2089 x 1764 pixels. Color fundus photograph: 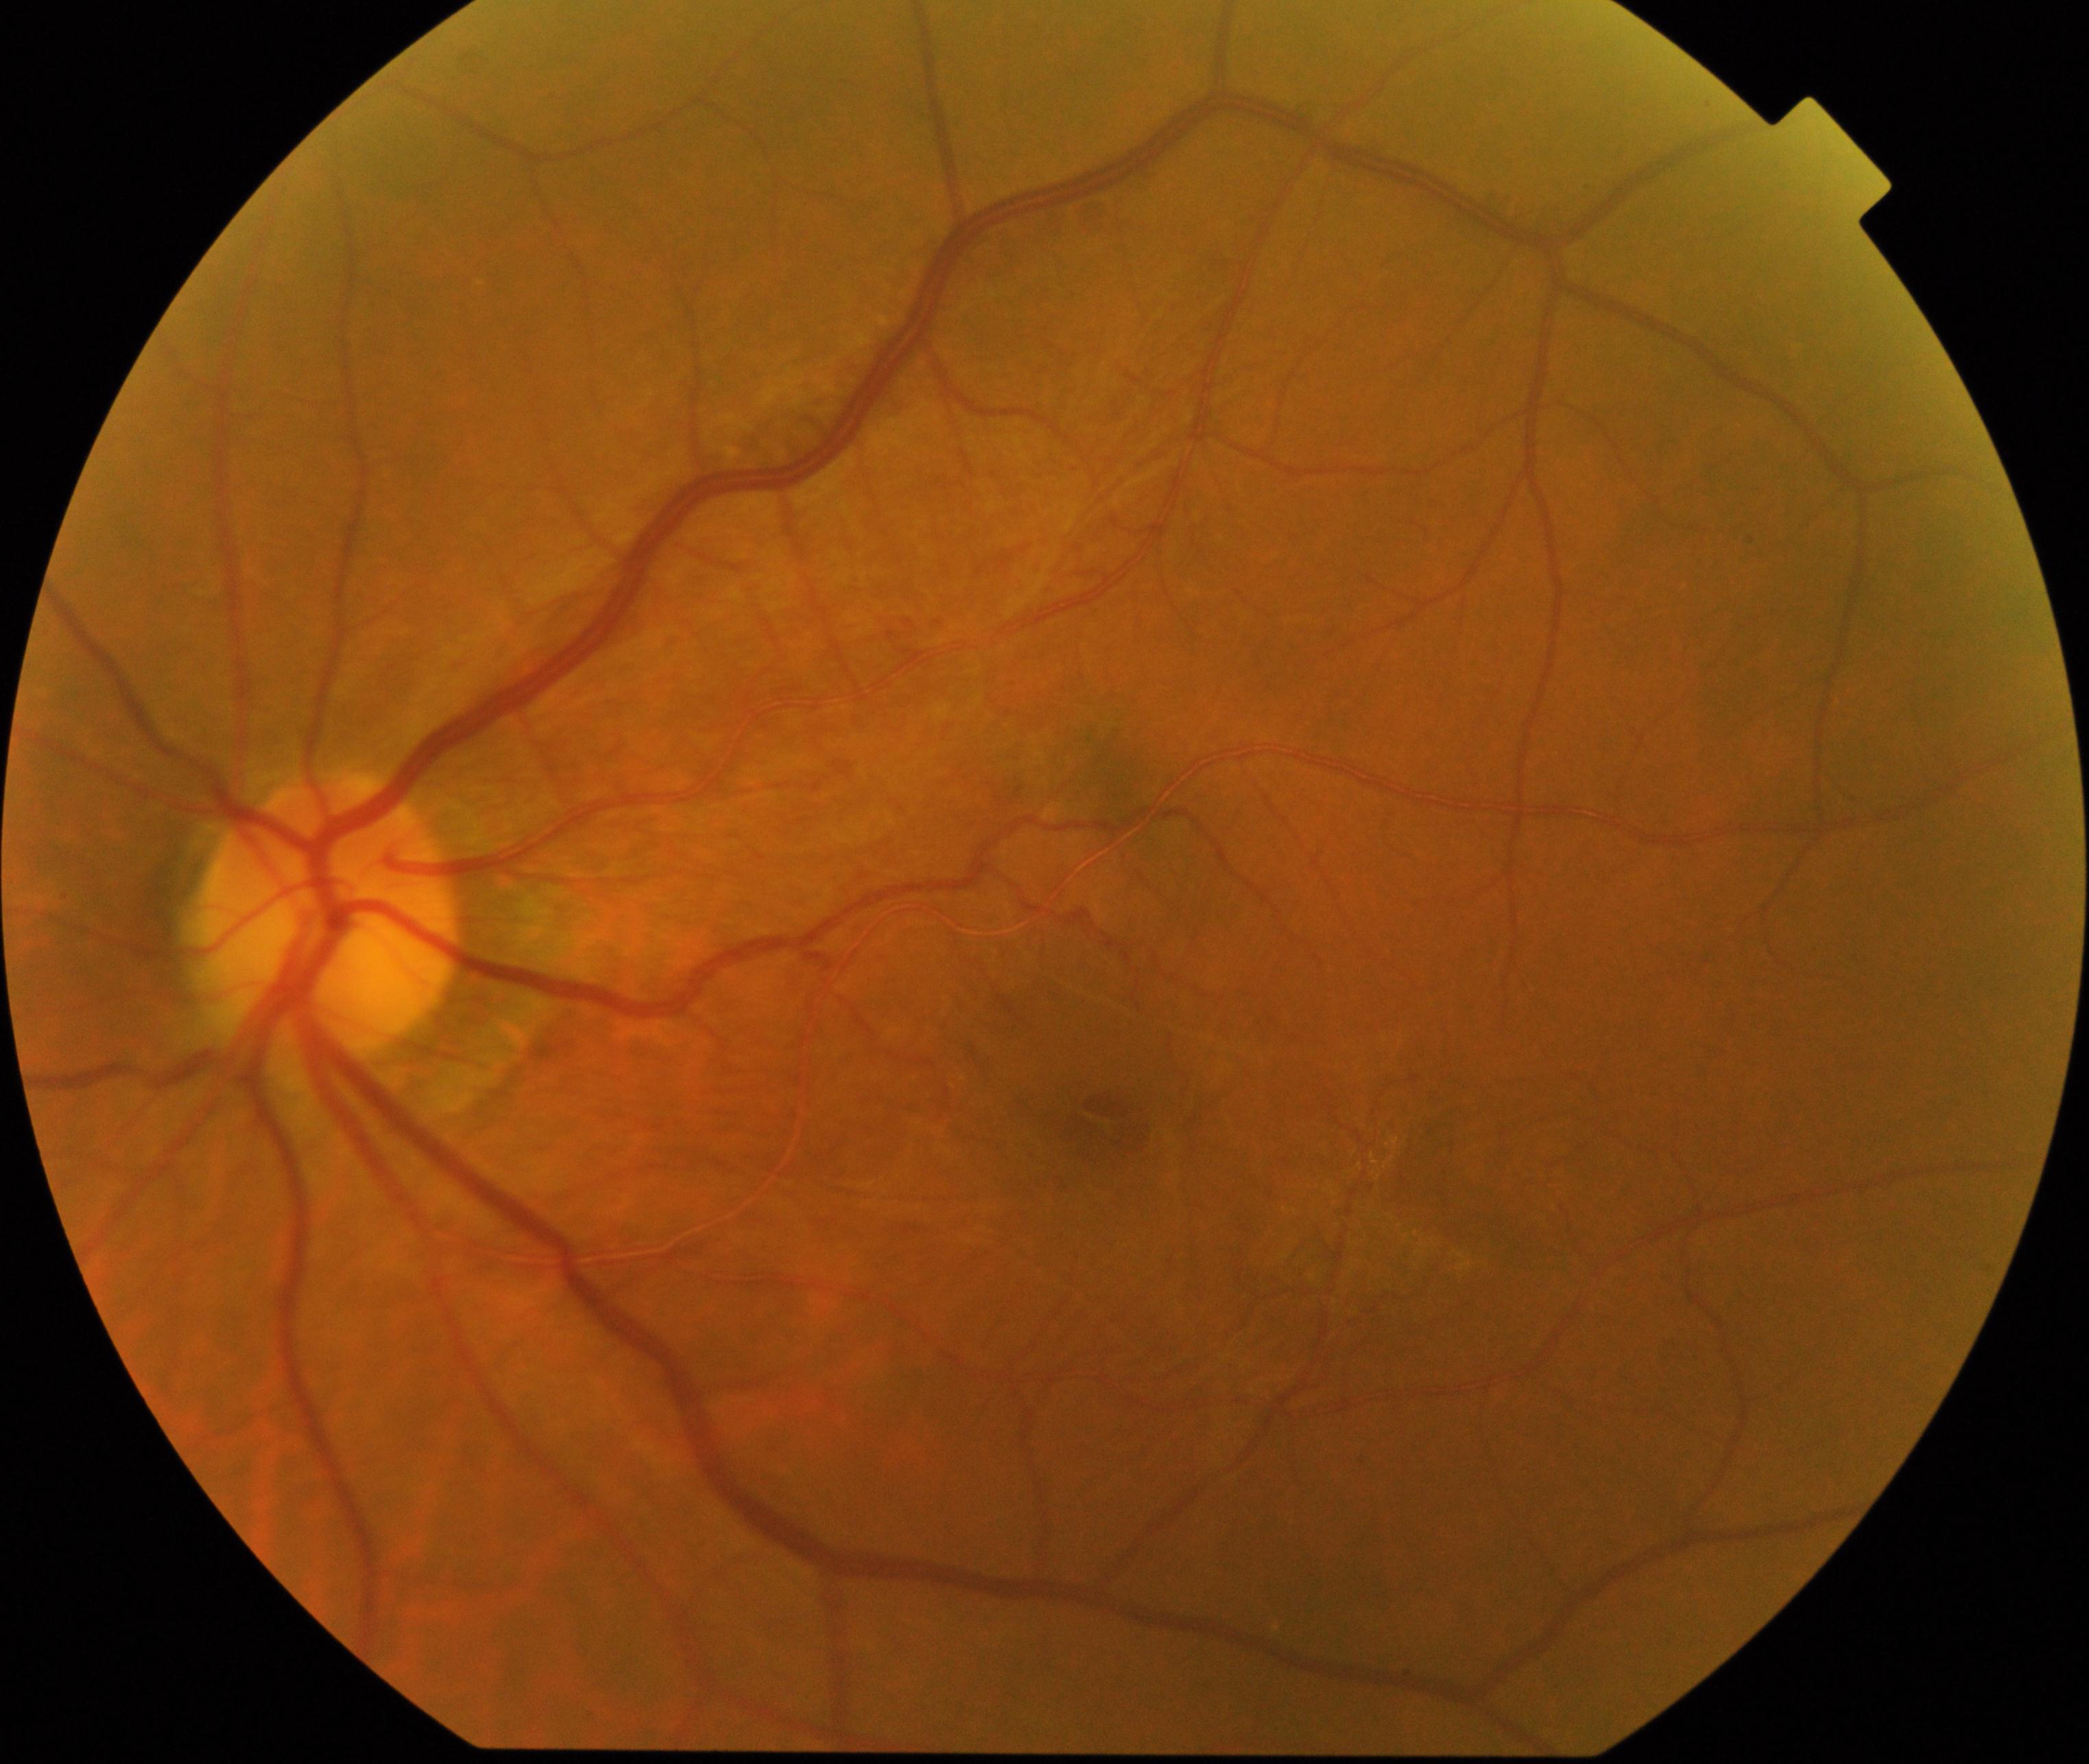
Primary finding: epiretinal membrane (ERM).